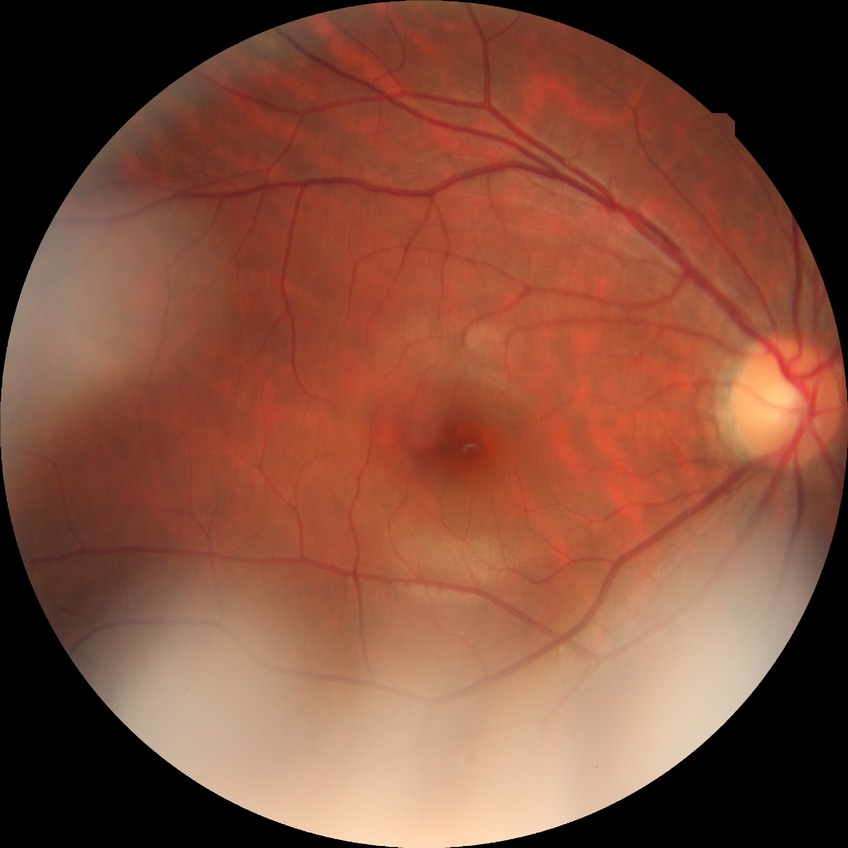

Diabetic retinopathy (DR): NDR (no diabetic retinopathy).